2048 by 1536 pixels: 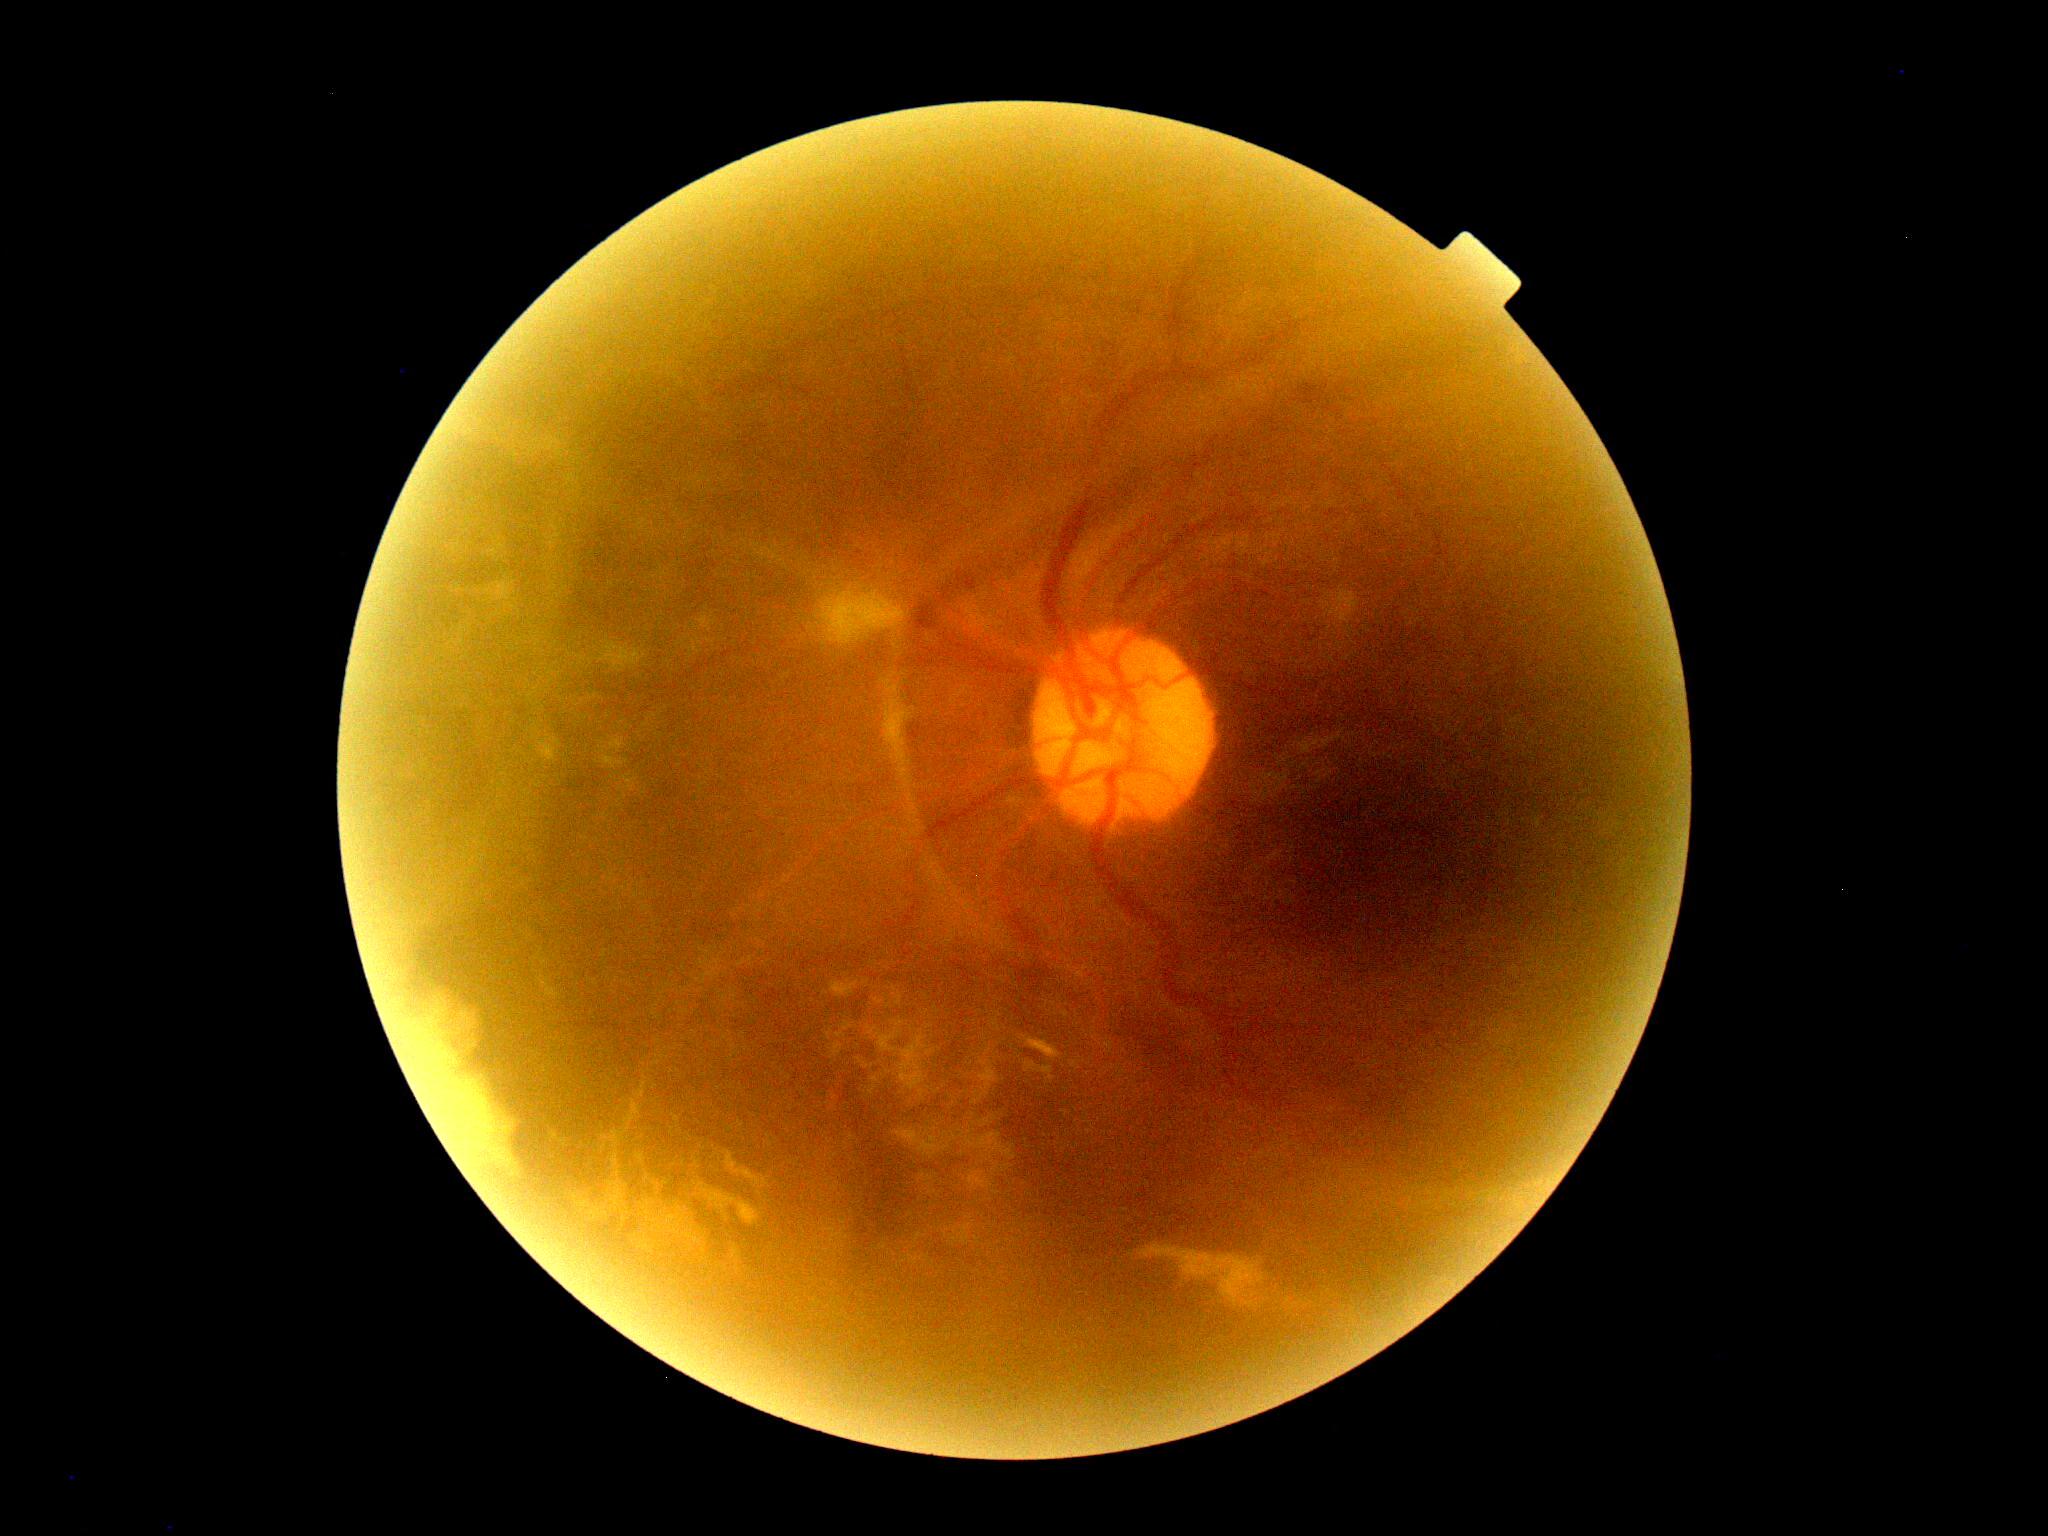 DR severity is grade 4.